Camera: NIDEK AFC-230 — 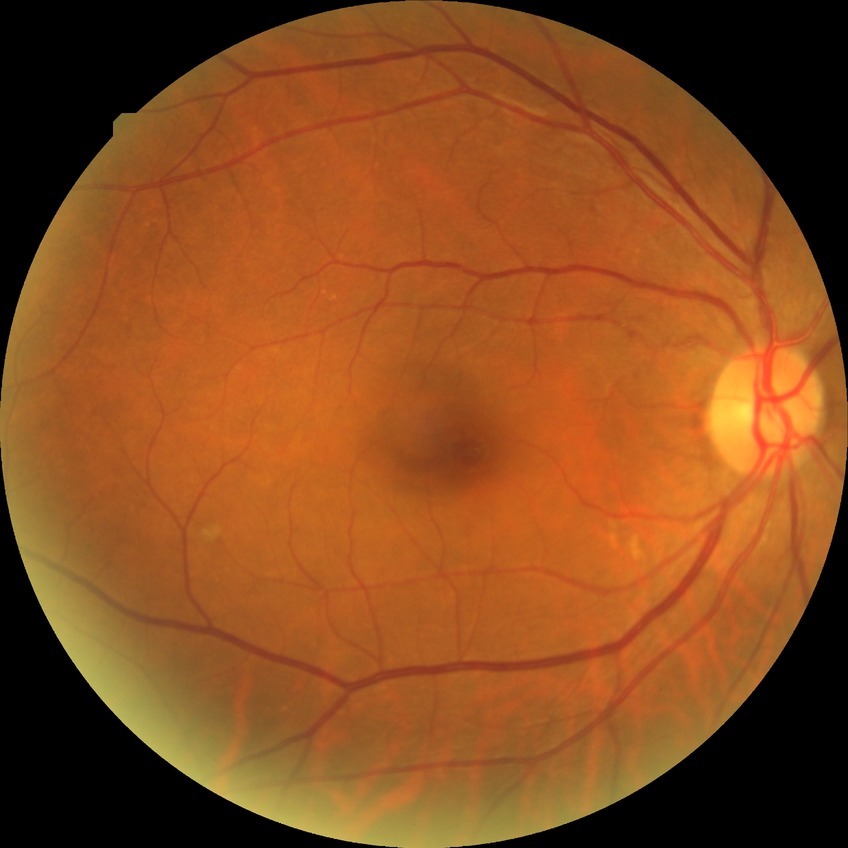

Diabetic retinopathy (DR) is no diabetic retinopathy (NDR).